NIDEK AFC-230; posterior pole photograph — 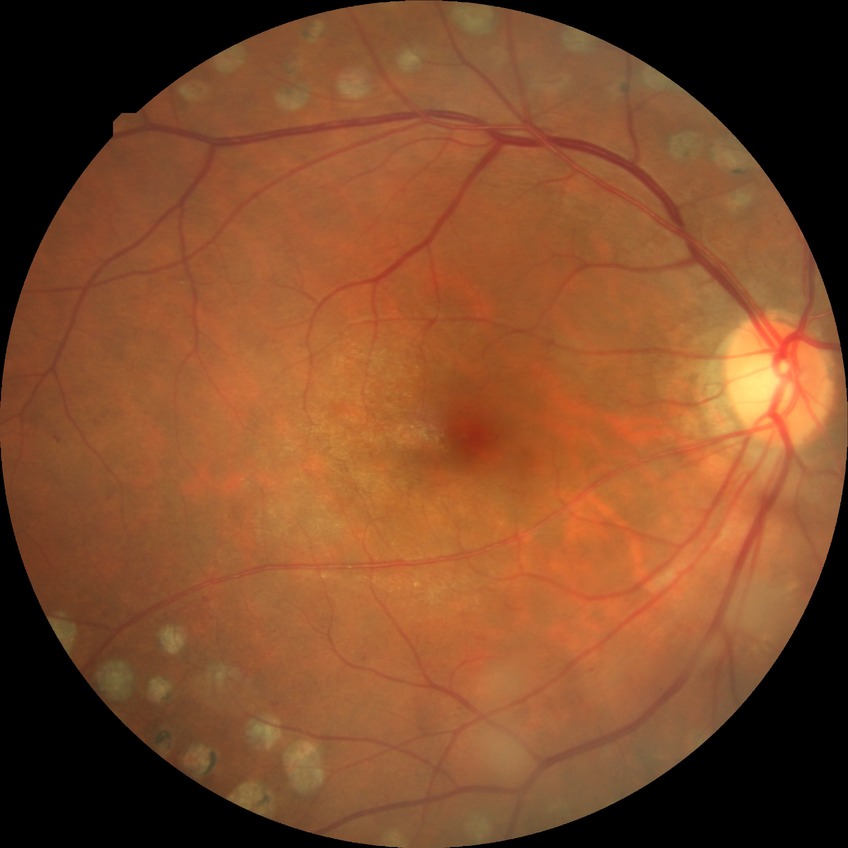 Diabetic retinopathy (DR) is PDR (proliferative diabetic retinopathy).